Image size 1240x1240 · wide-field fundus image from infant ROP screening — 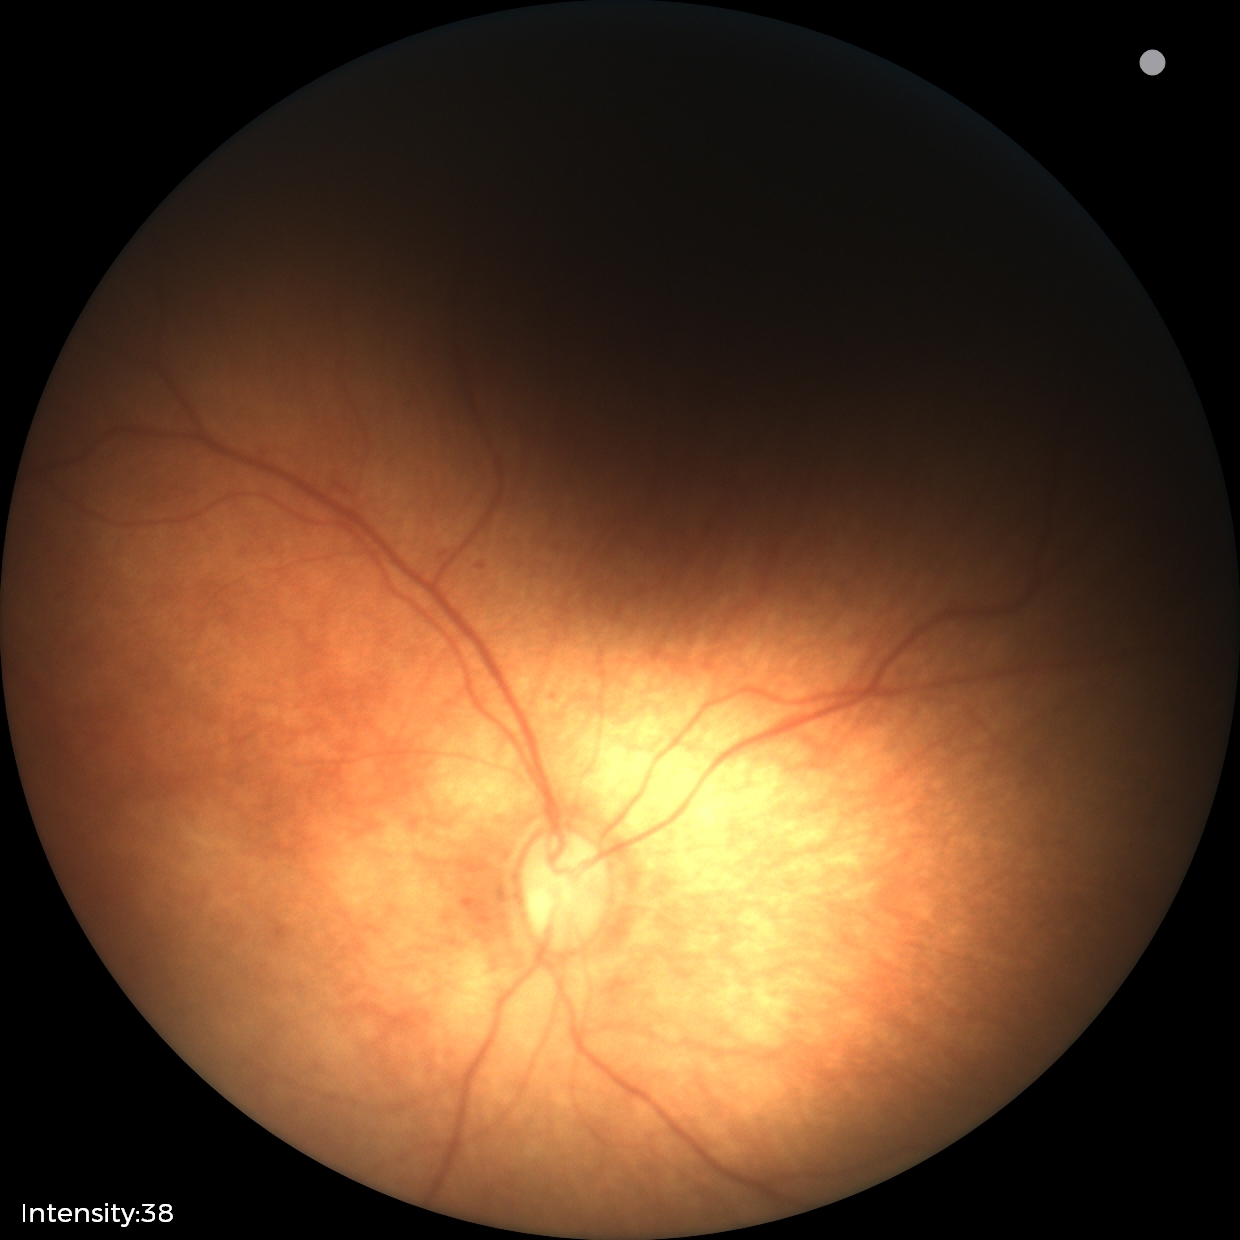

Normal screening examination.